Retinal fundus photograph: 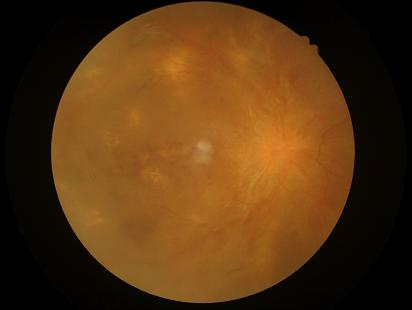
Sharpness: out of focus, structures indistinct
Contrast: low, vessels and details hard to distinguish
Illumination/color: uneven illumination or color cast
Overall quality: inadequate for clinical interpretation